Field includes the optic disc and macula: 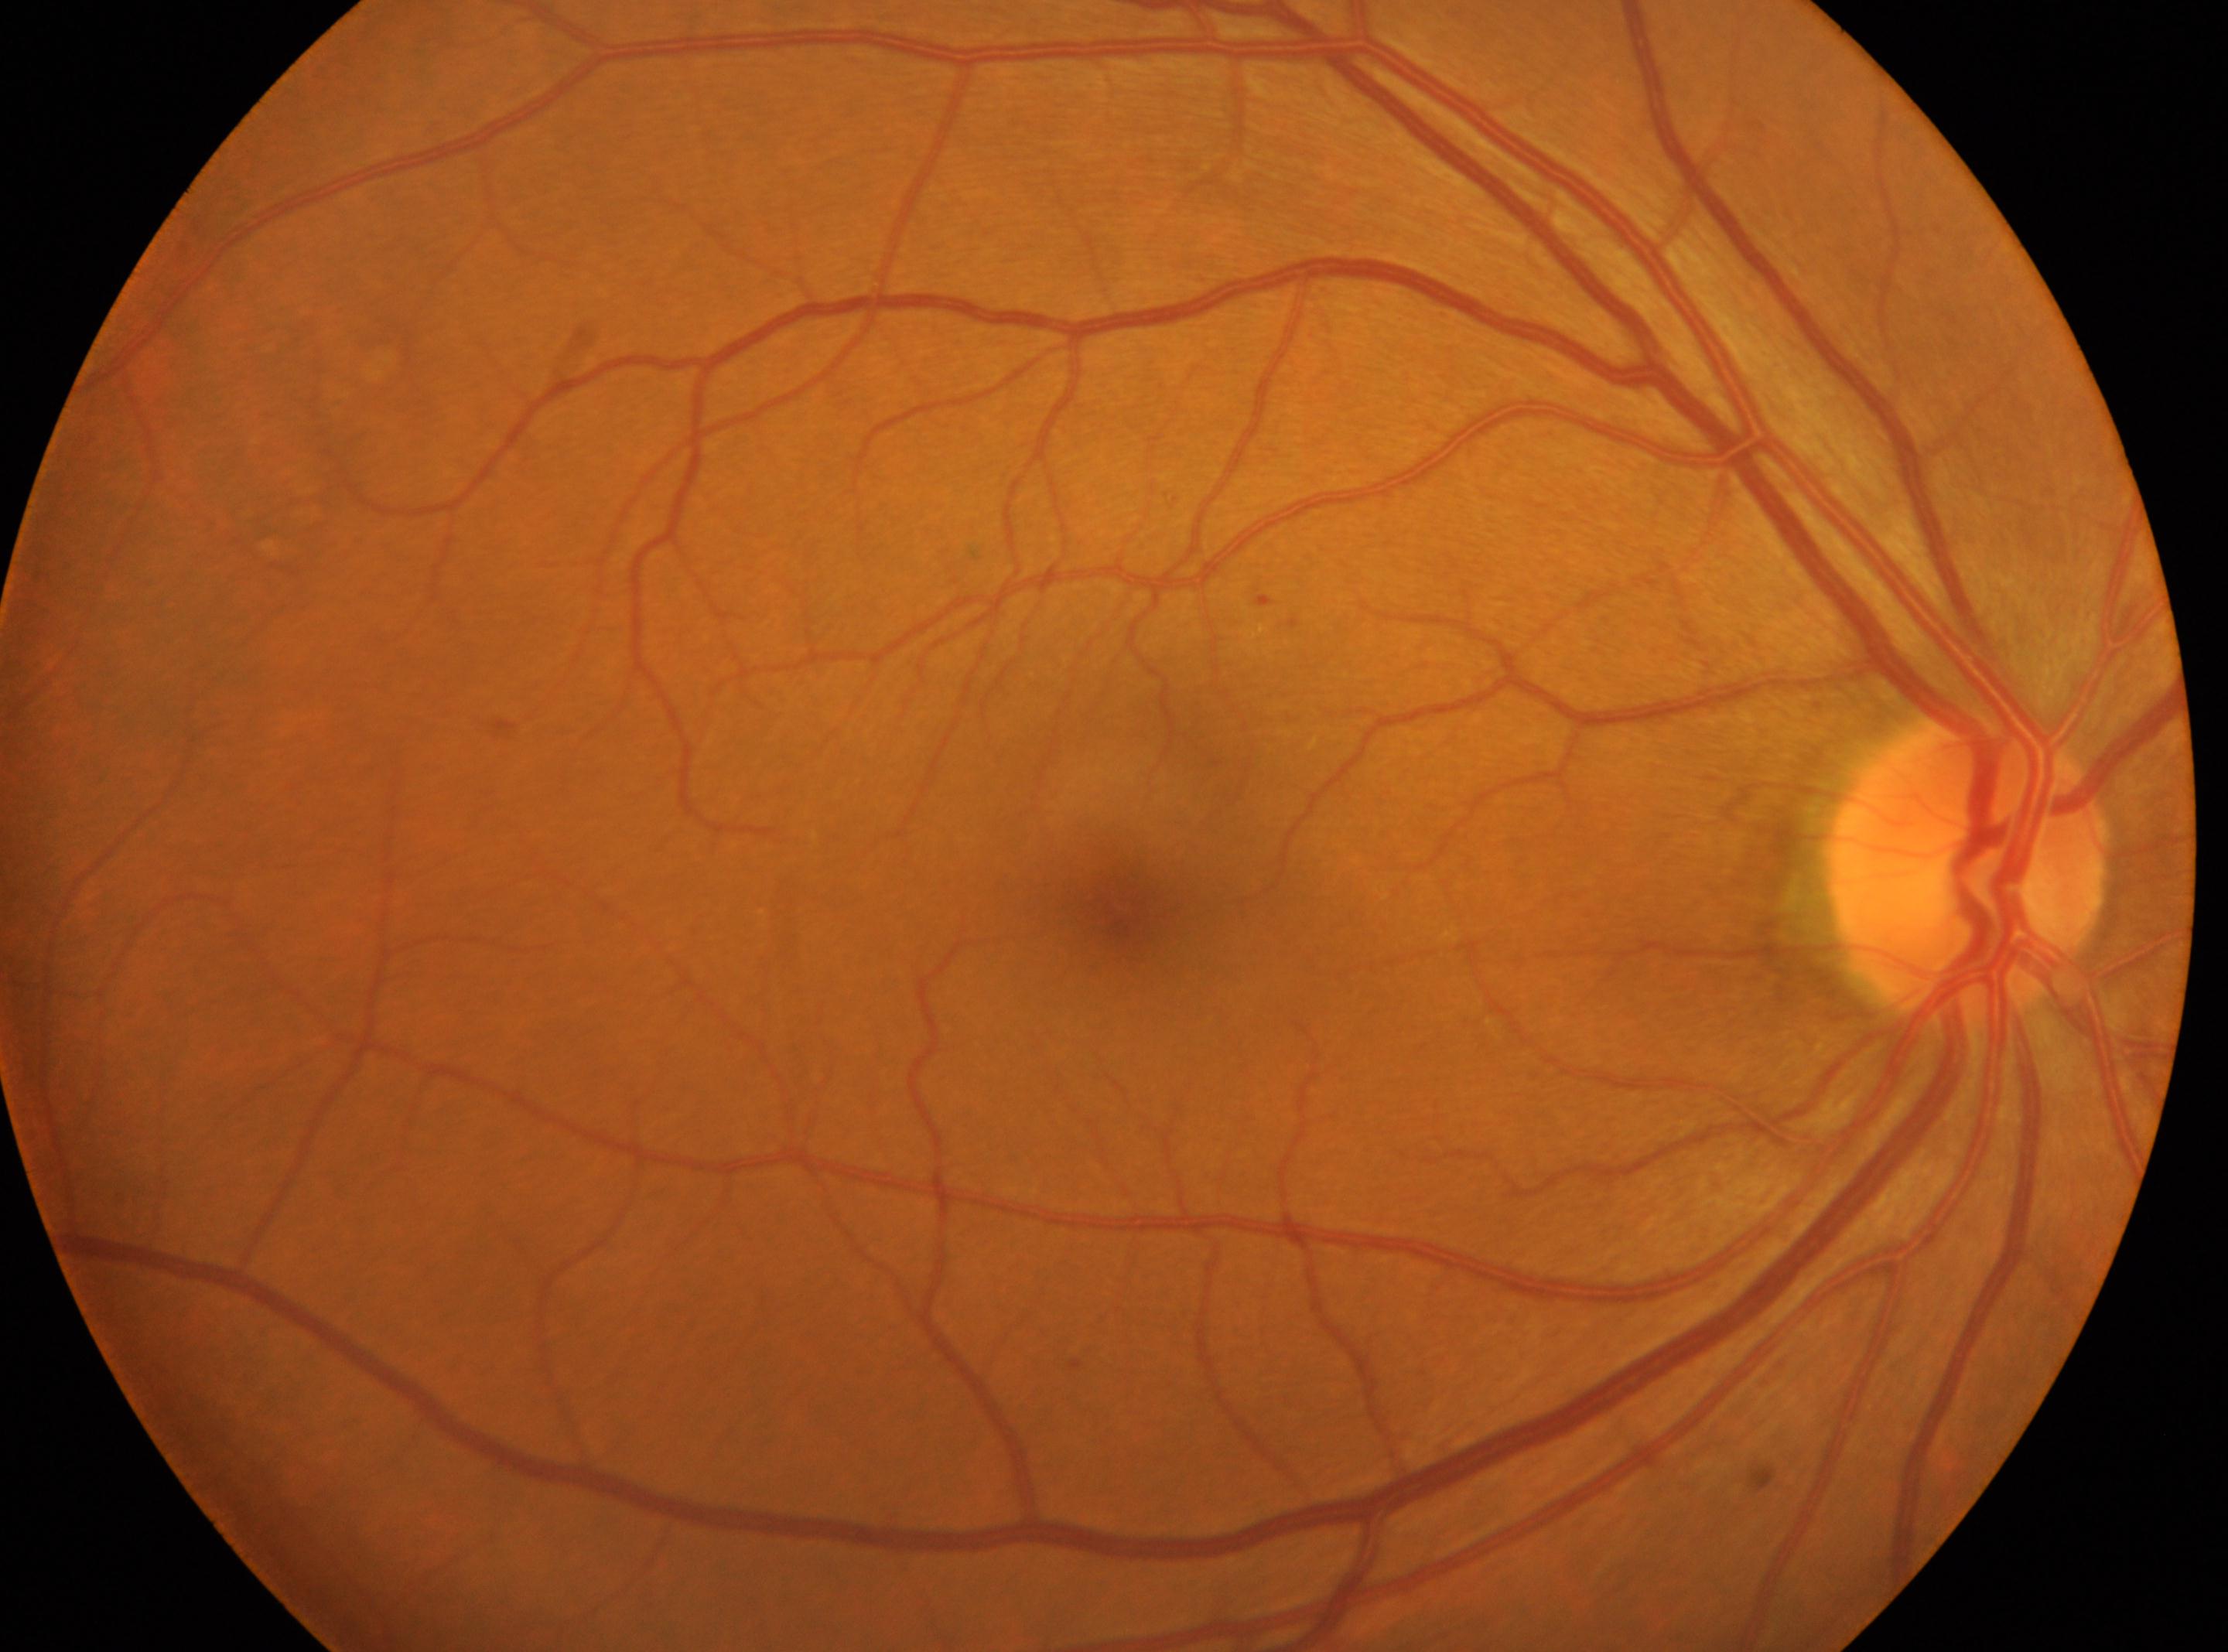

The image shows the oculus dexter. Diabetic retinopathy: mild non-proliferative diabetic retinopathy (grade 1). Fovea: (1111,911). The disc center is at (1967,867).